Fundus photo; 45-degree field of view; 848 x 848 pixels; NIDEK AFC-230 fundus camera:
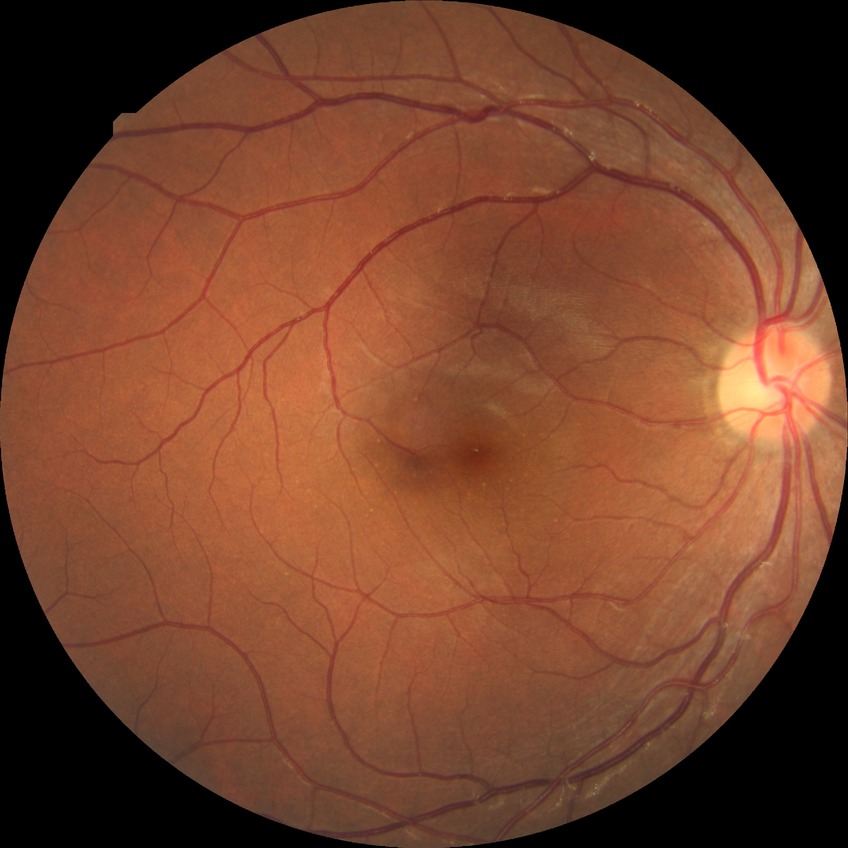
Modified Davis classification: no diabetic retinopathy.